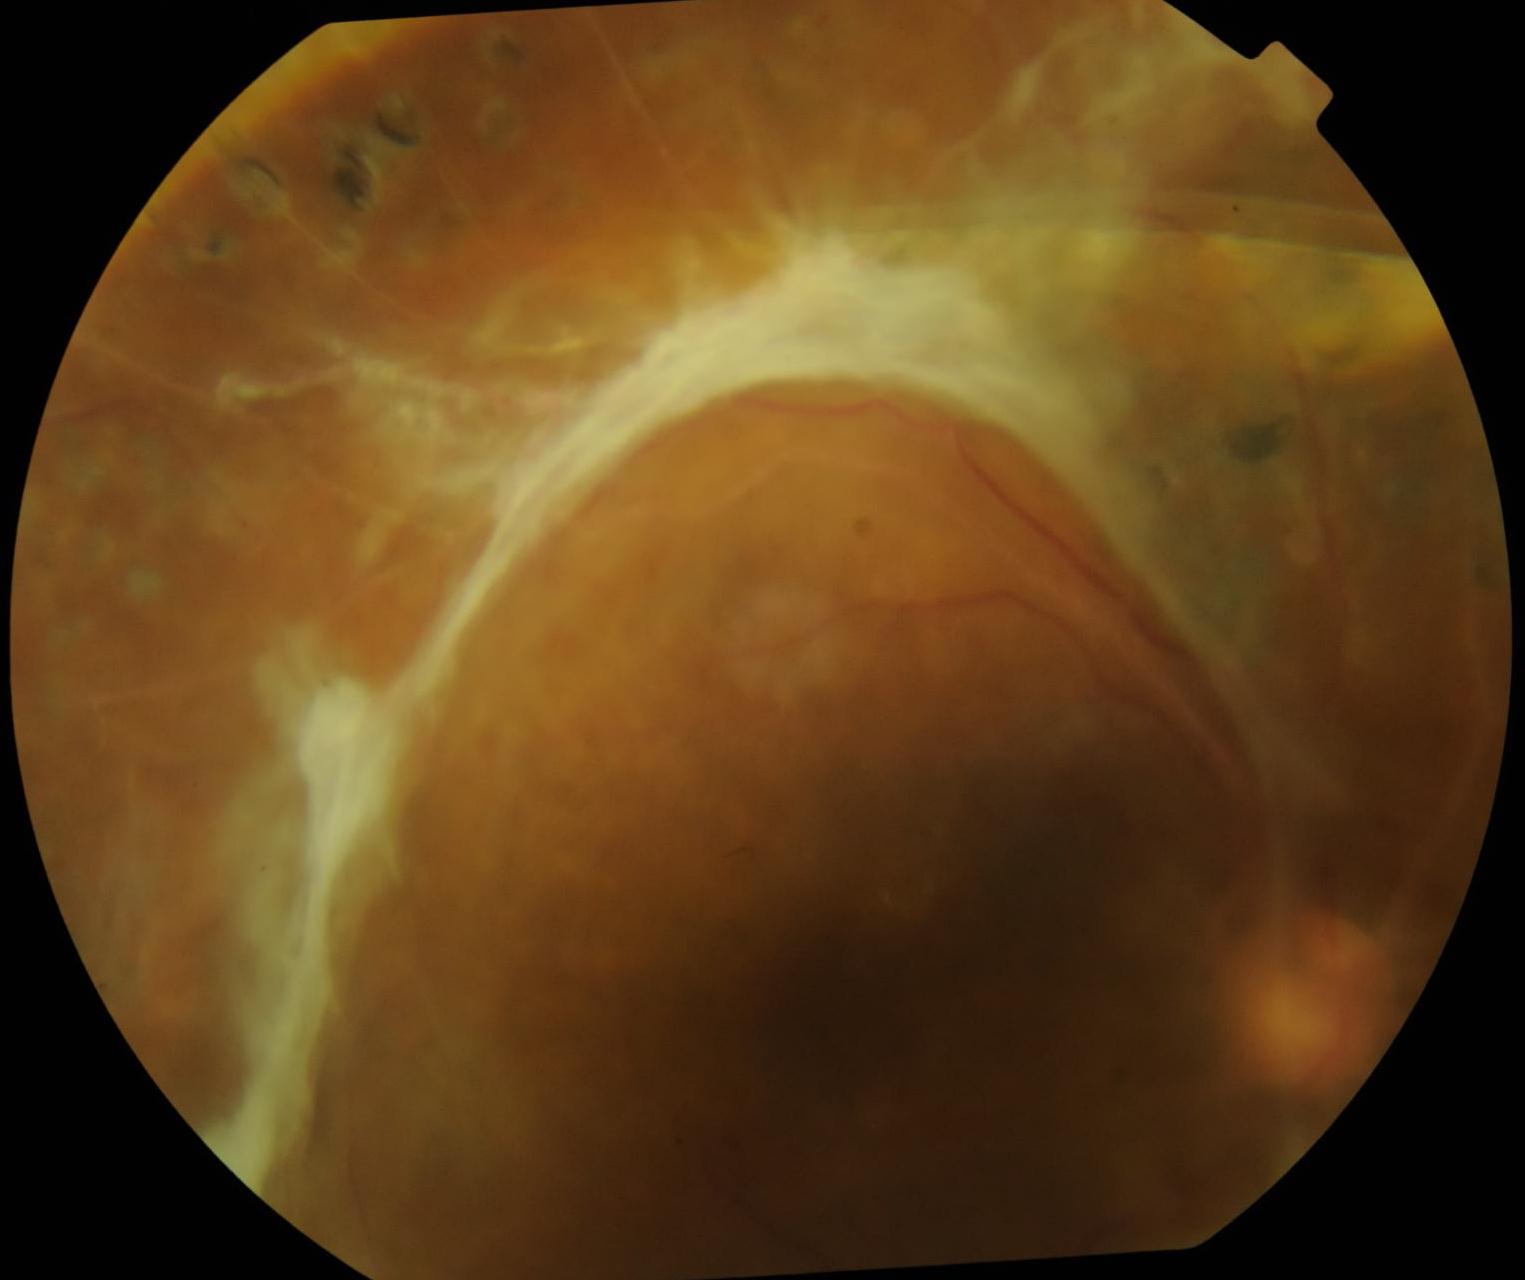

retinopathy@4/4, DR class@proliferative diabetic retinopathy.